640 x 480 pixels · wide-field fundus image from infant ROP screening: 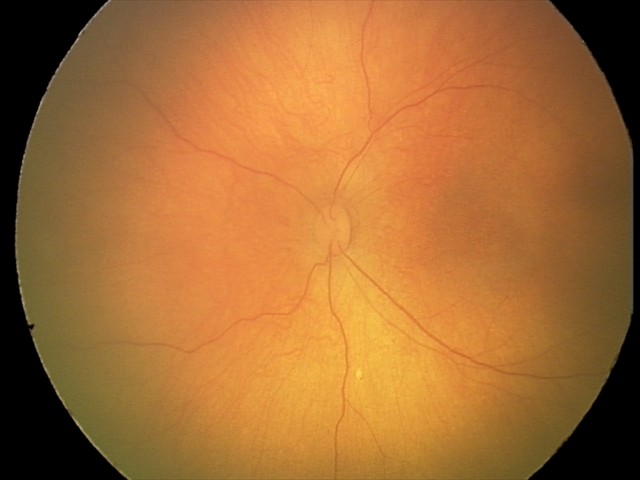
Assessment: no abnormalities.